Optic disc-centered crop from a color fundus photograph.
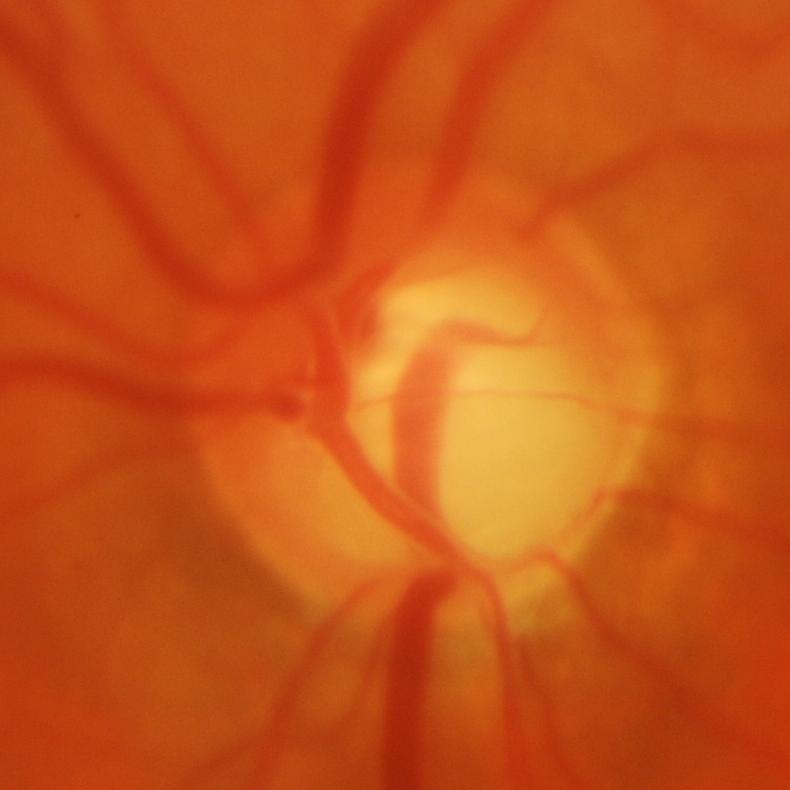
Glaucoma is present. Assessment = glaucomatous findings.